Modified Davis grading
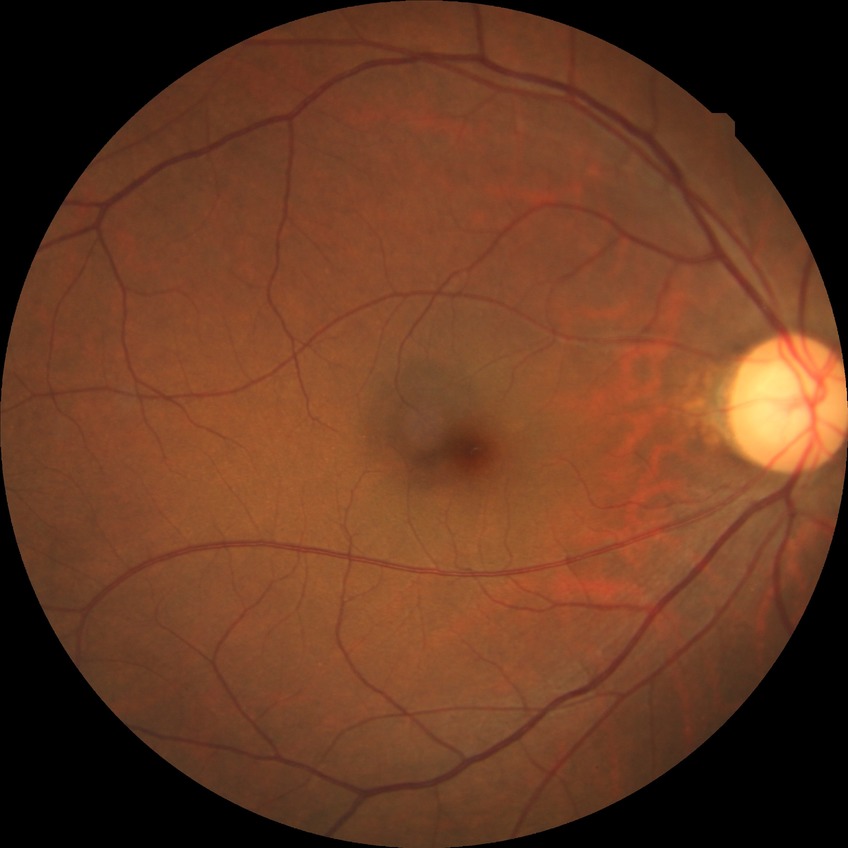 Assessment:
* diabetic retinopathy (DR): NDR (no diabetic retinopathy)